45° FOV · 2352 by 1568 pixels · retinal fundus photograph.
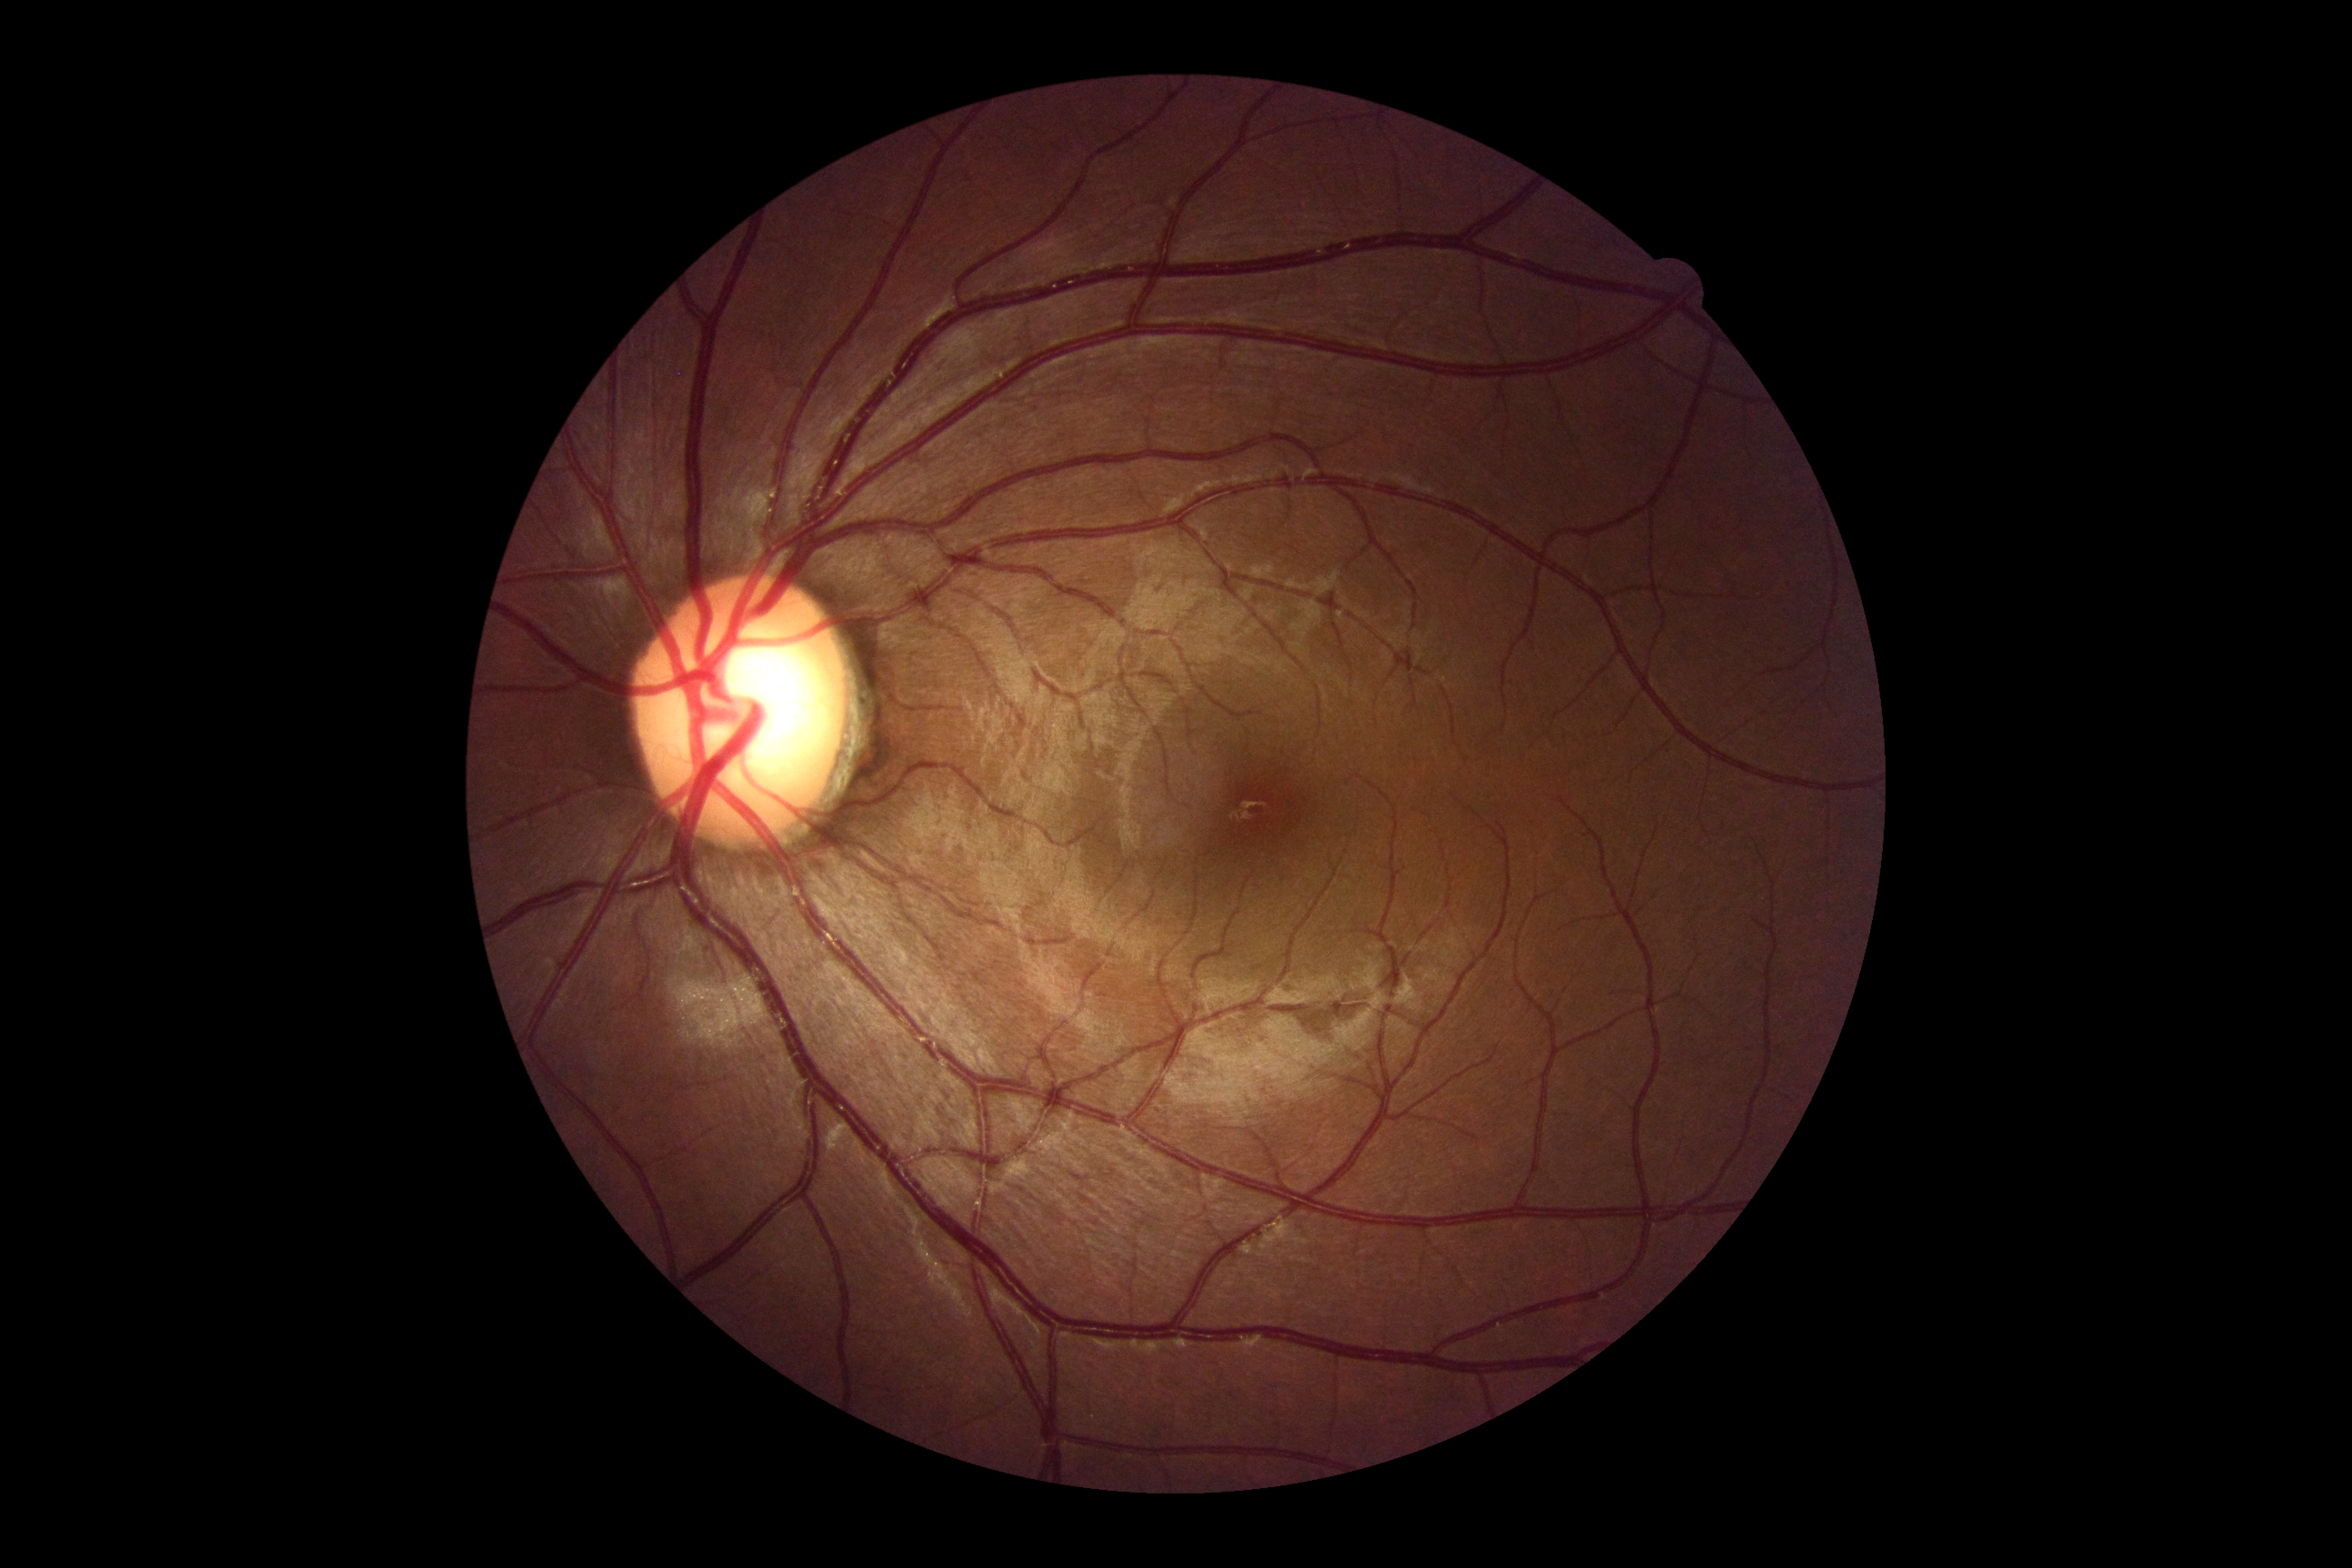
DR grade: 0/4.
No apparent diabetic retinopathy.